Captured without pupil dilation: 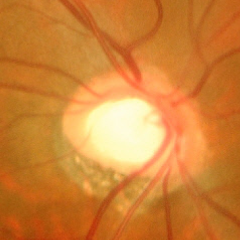 Showing advanced-stage glaucoma.